Captured with the Natus RetCam Envision (130° field of view); wide-field contact fundus photograph of an infant.
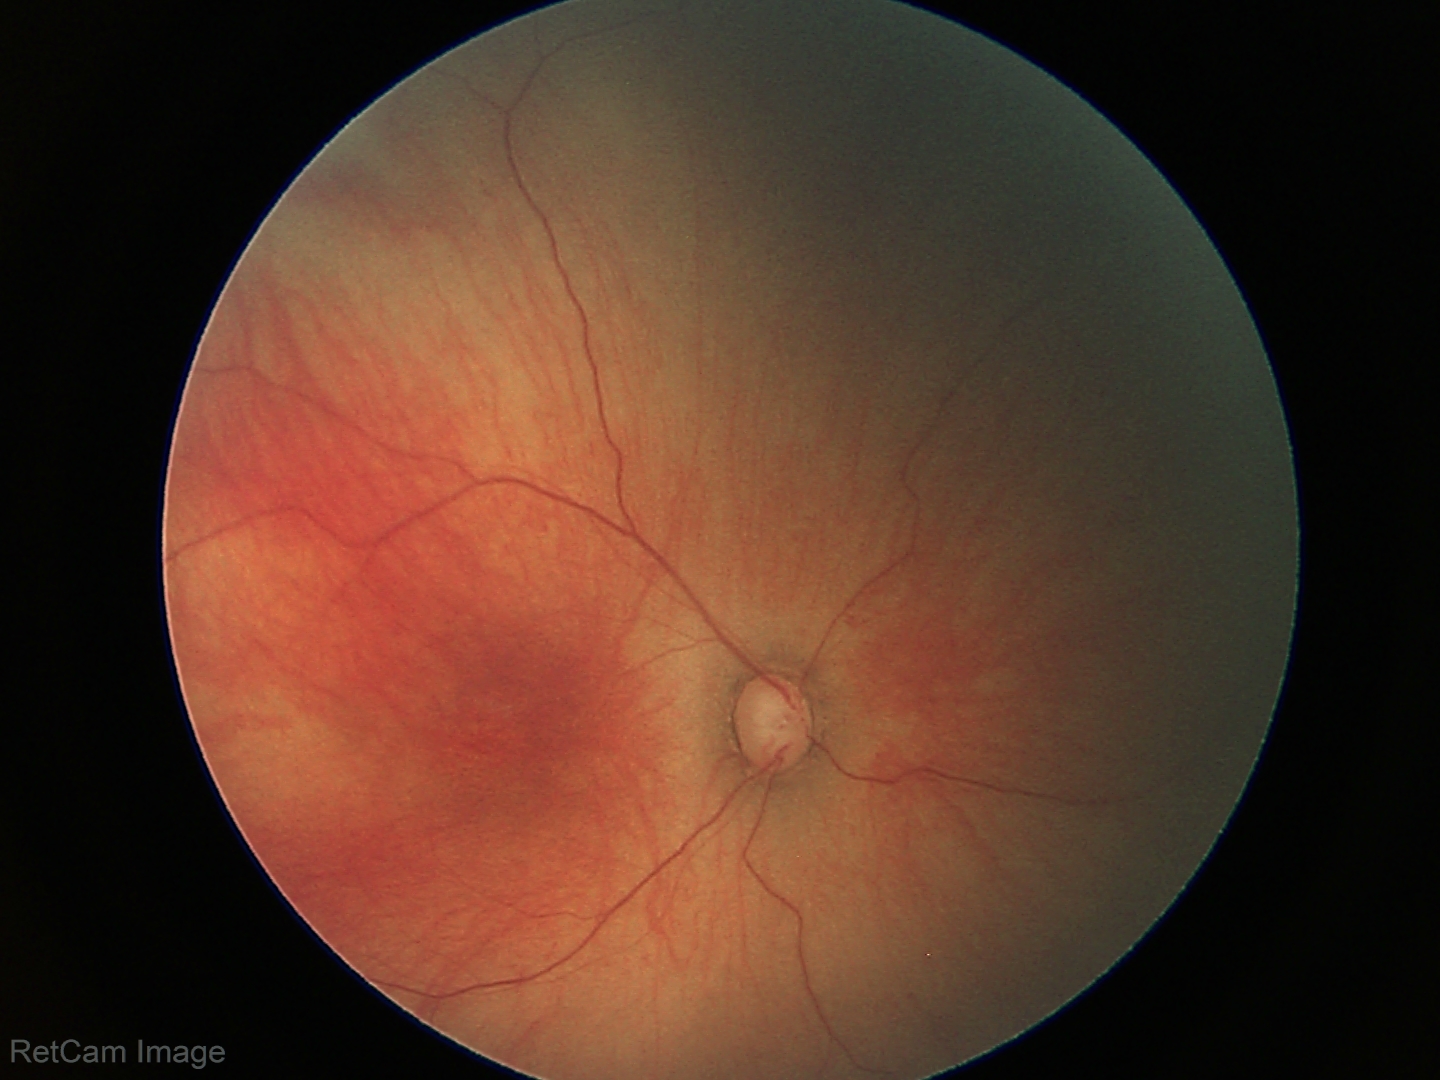 Physiological retinal appearance for postconceptual age.